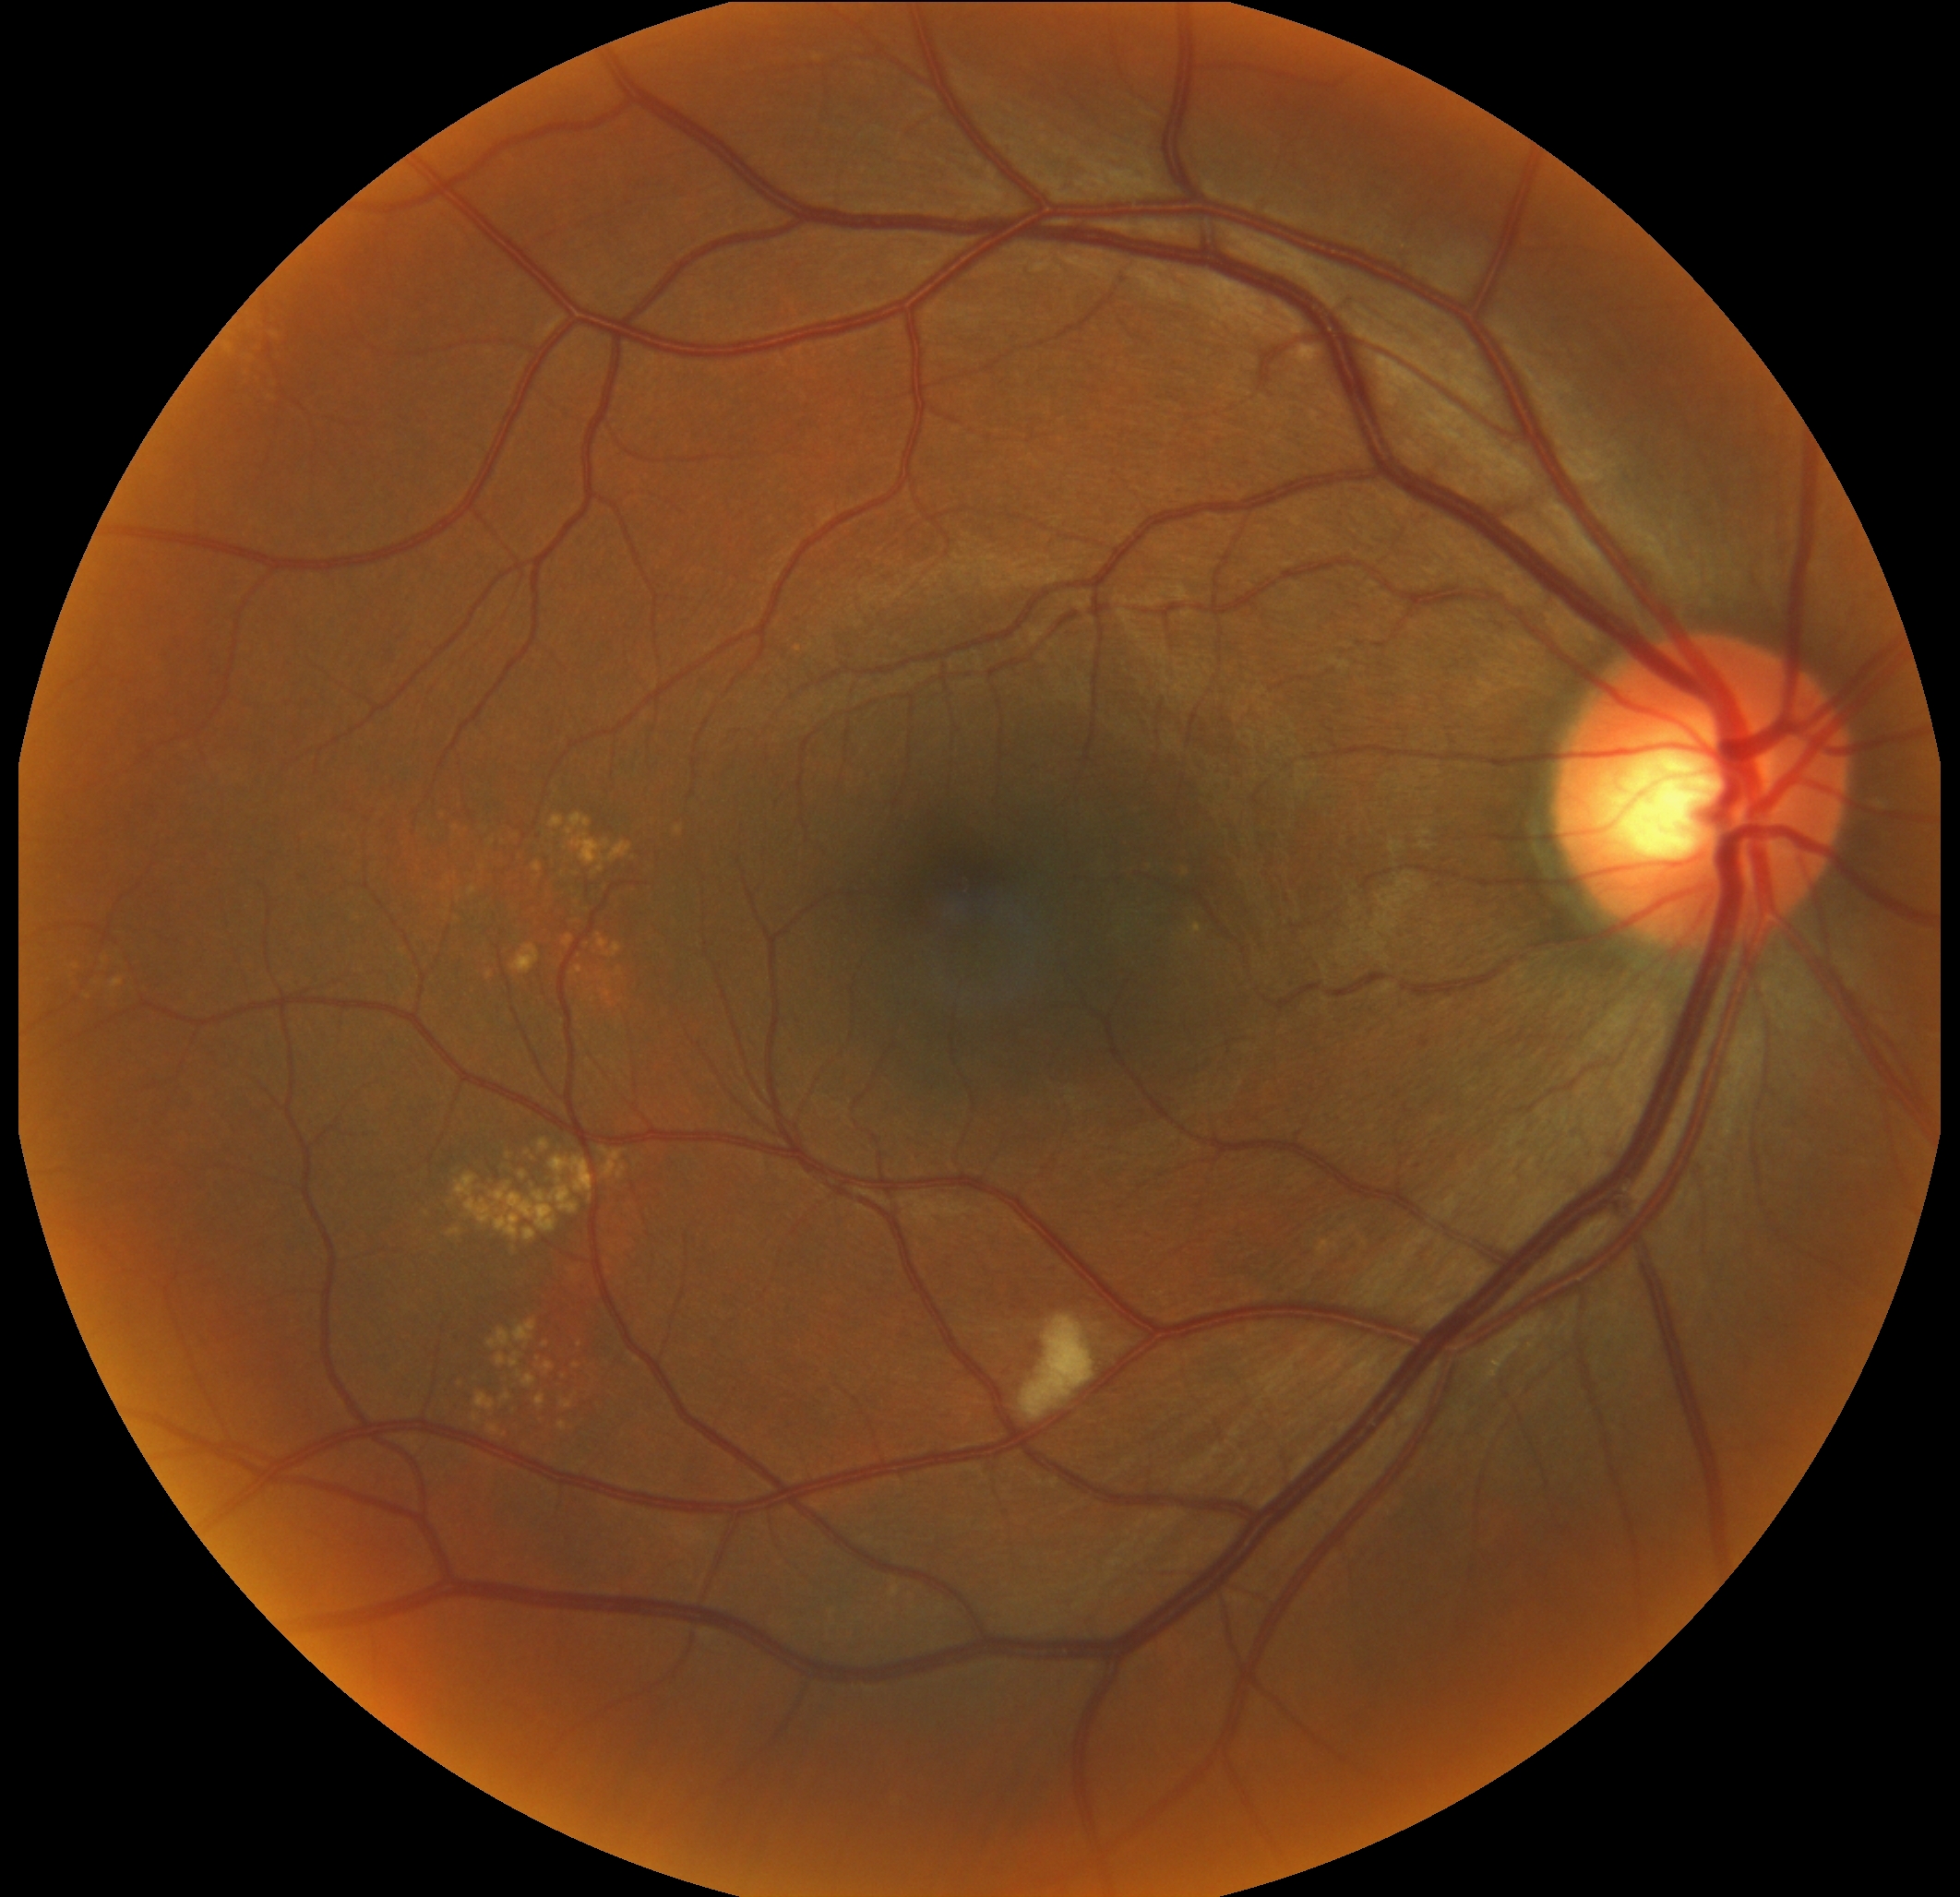

DR class: non-proliferative diabetic retinopathy, diabetic retinopathy: 2/4.